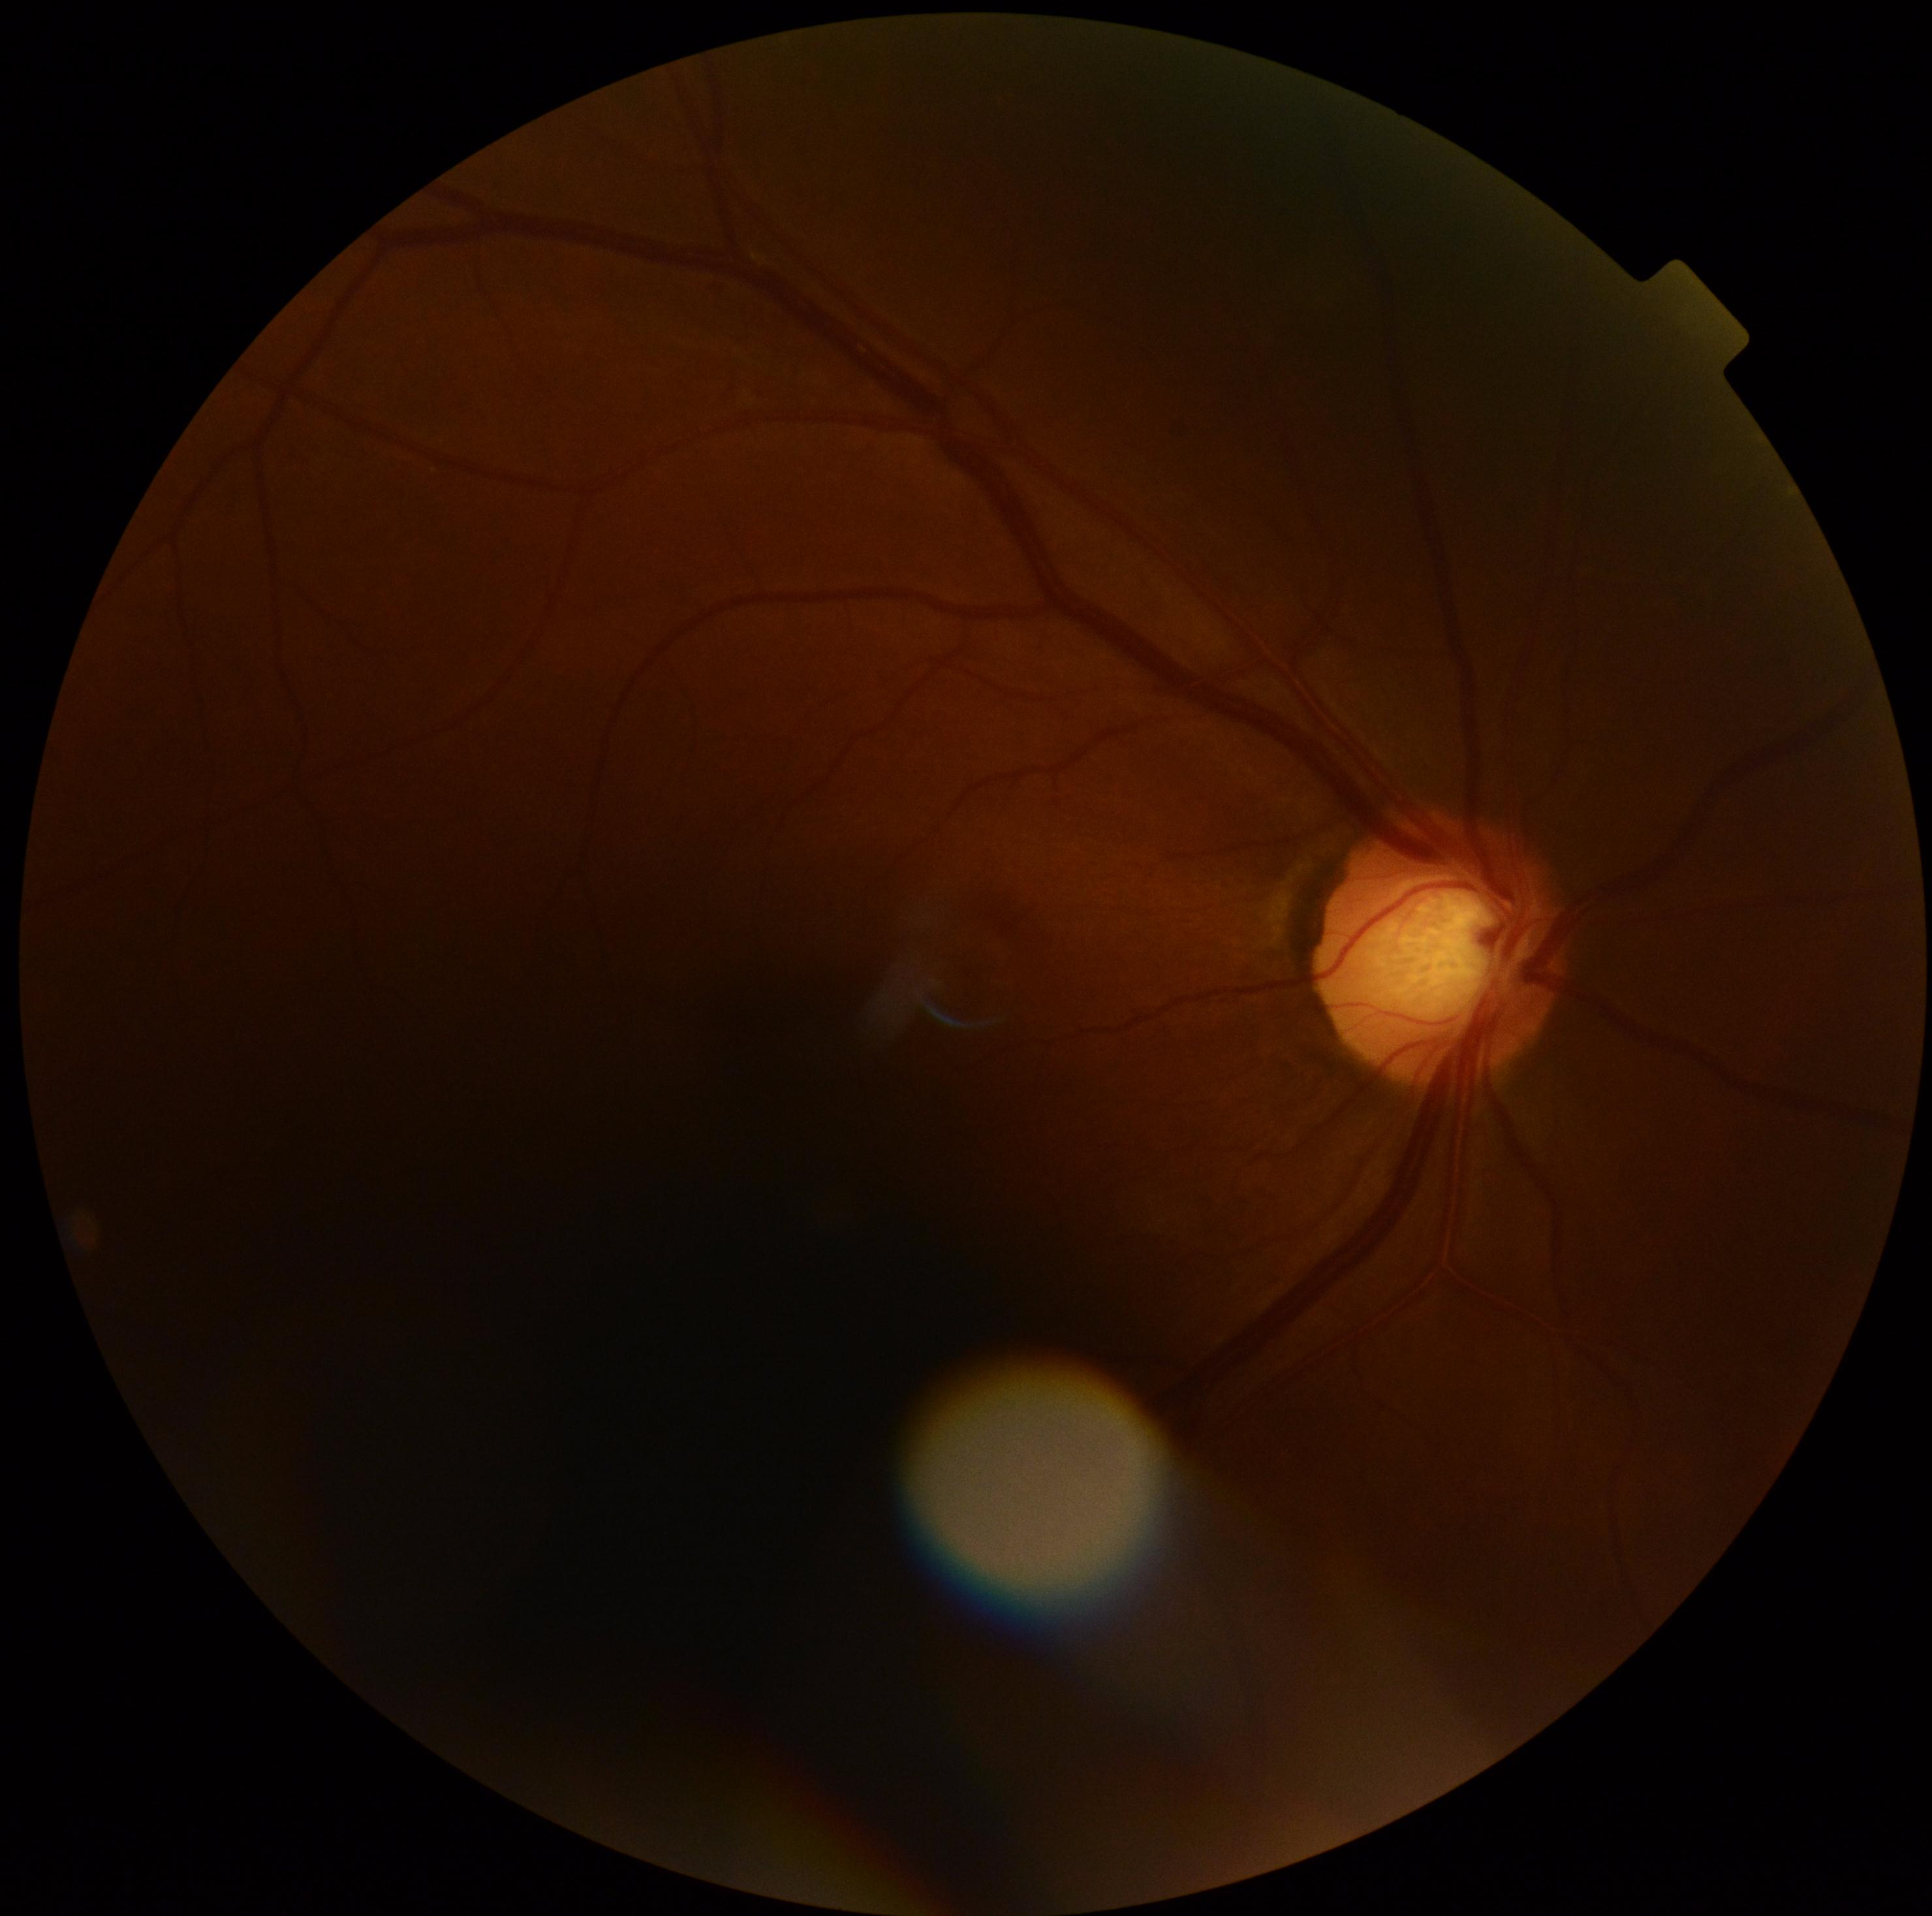 diabetic retinopathy (DR): 0 — no visible signs of diabetic retinopathy | DR impression: no DR findings.